45 degree fundus photograph · diabetic retinopathy graded by the modified Davis classification · no pharmacologic dilation · color fundus photograph · 848x848px · NIDEK AFC-230 fundus camera — 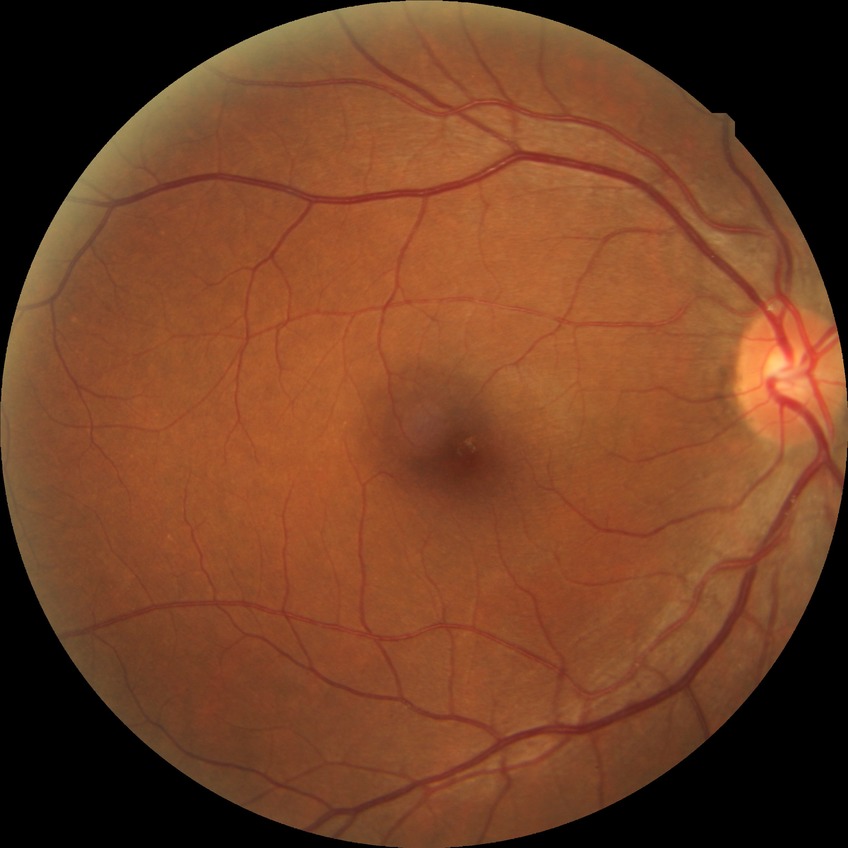 diabetic retinopathy (DR)=NDR (no diabetic retinopathy).